2352x1568
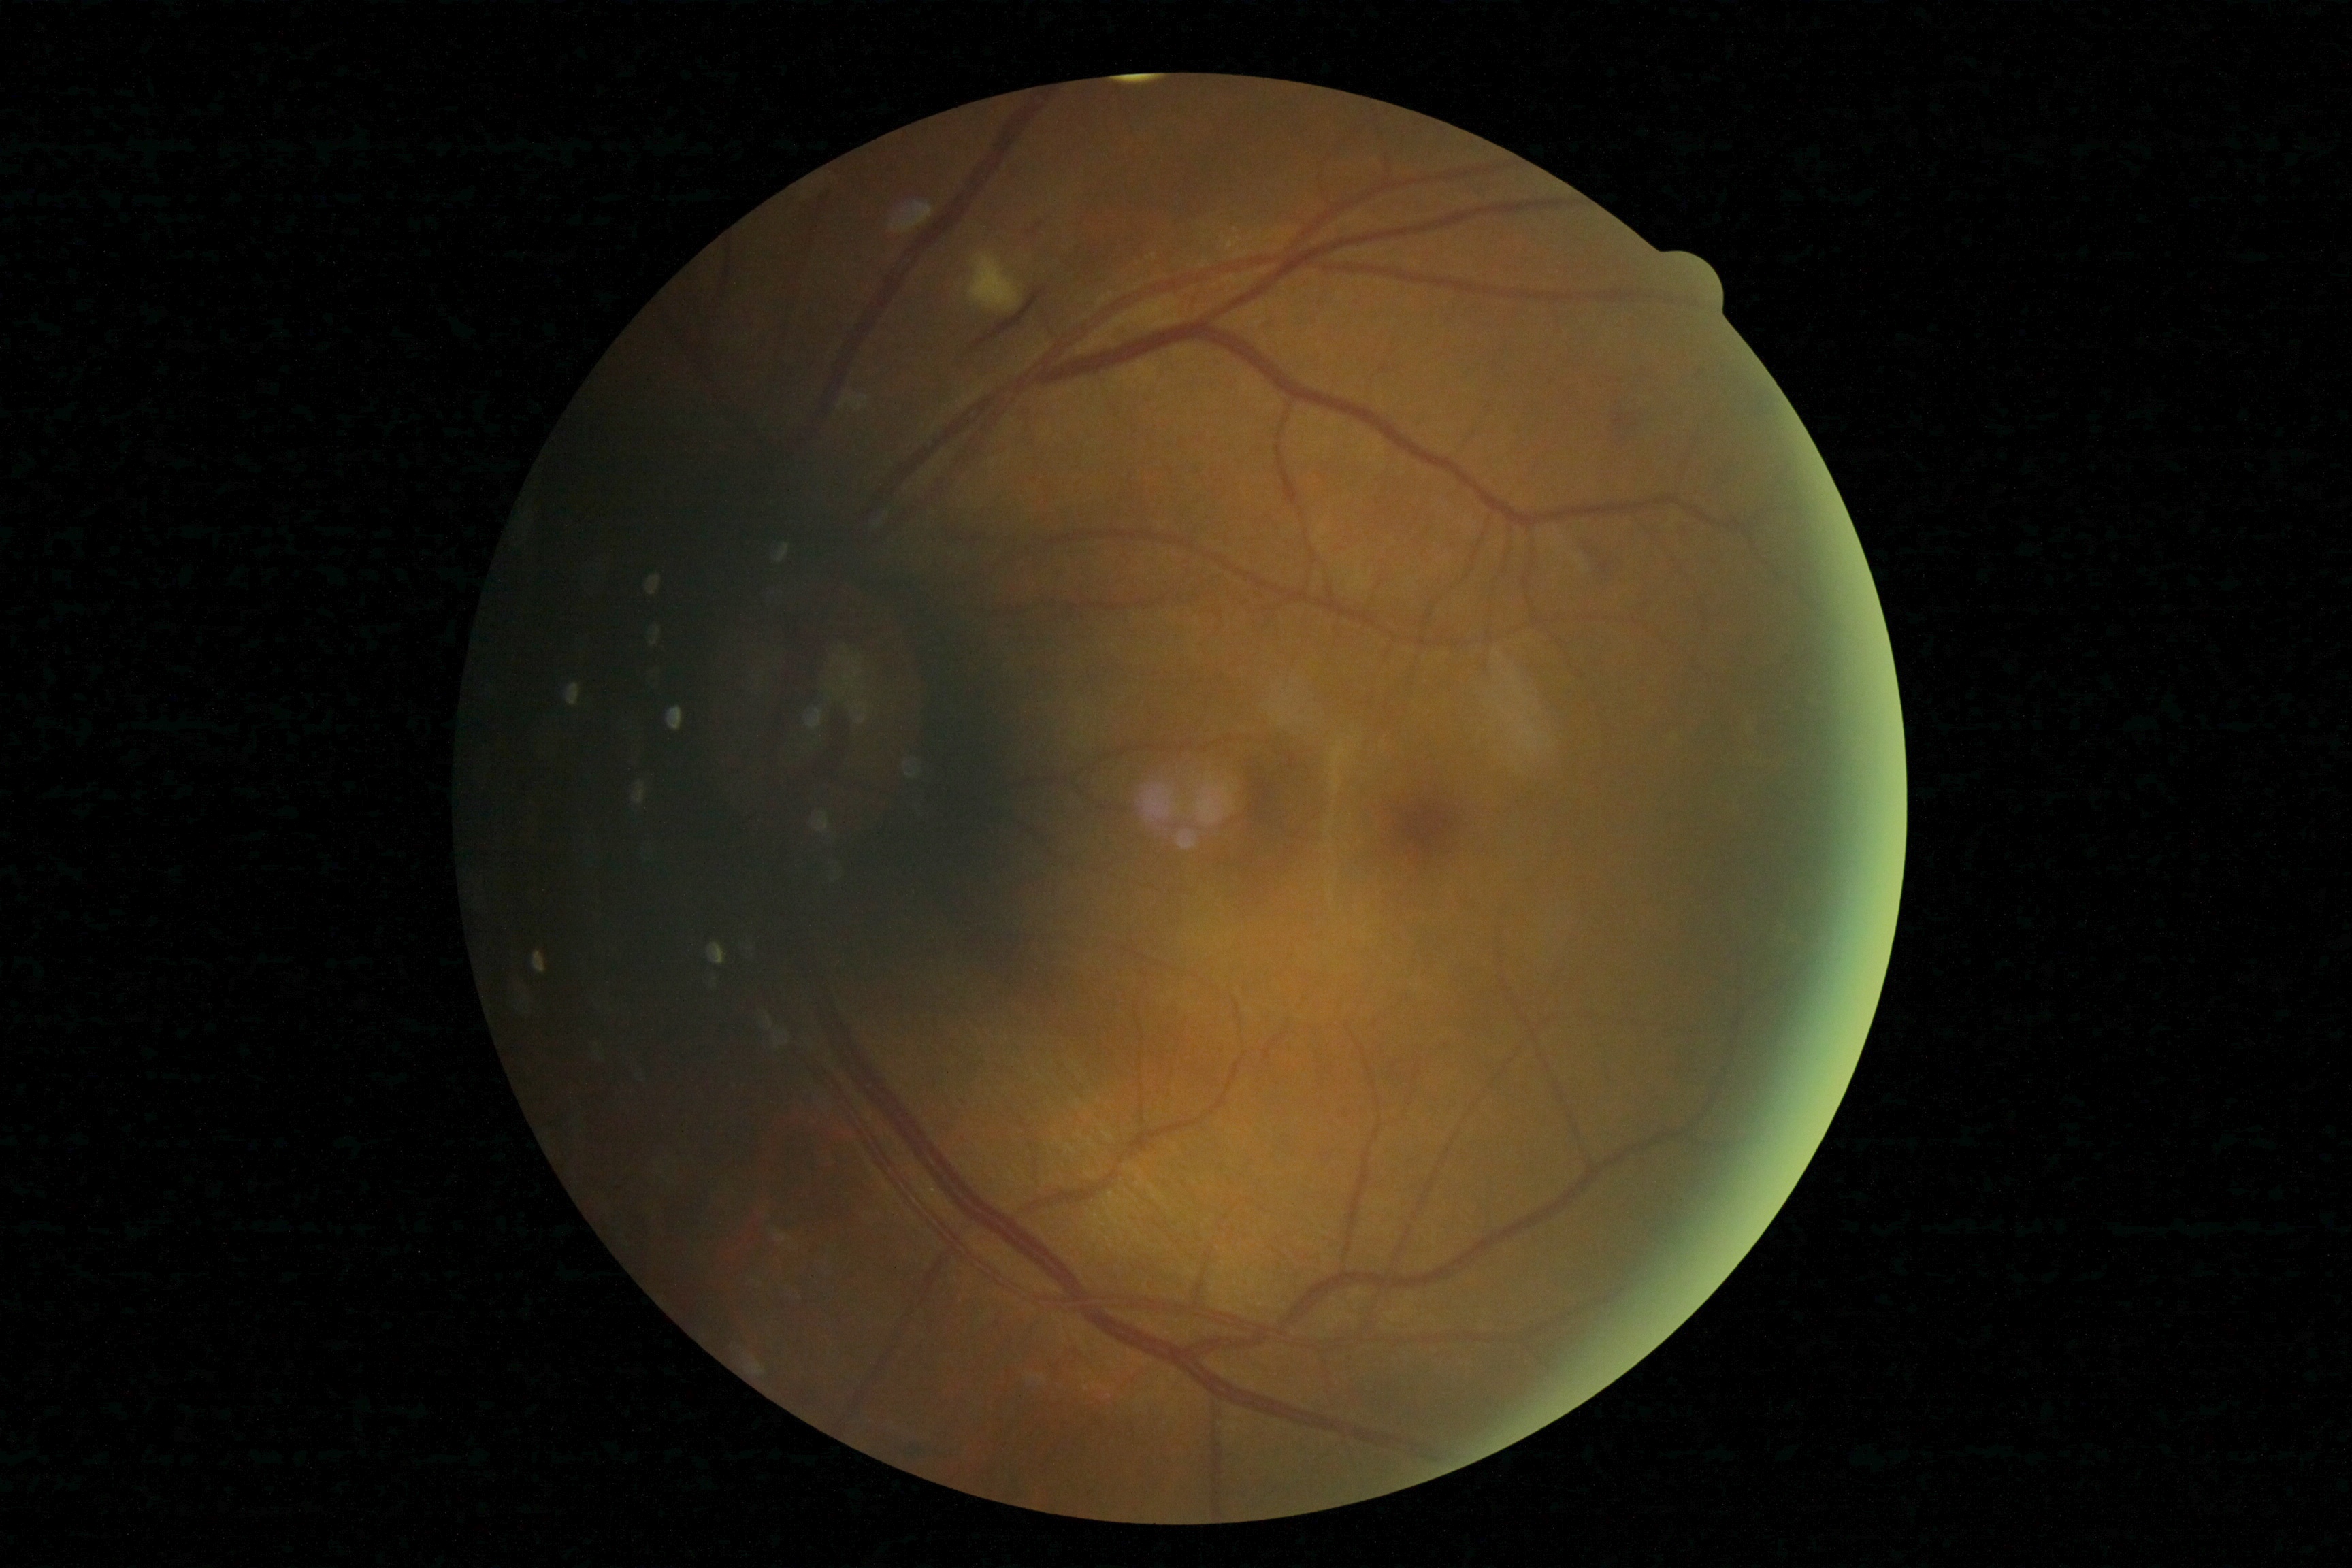
DR stage: grade 2 — more than just microaneurysms but less than severe NPDR.